Retinal fundus photograph:
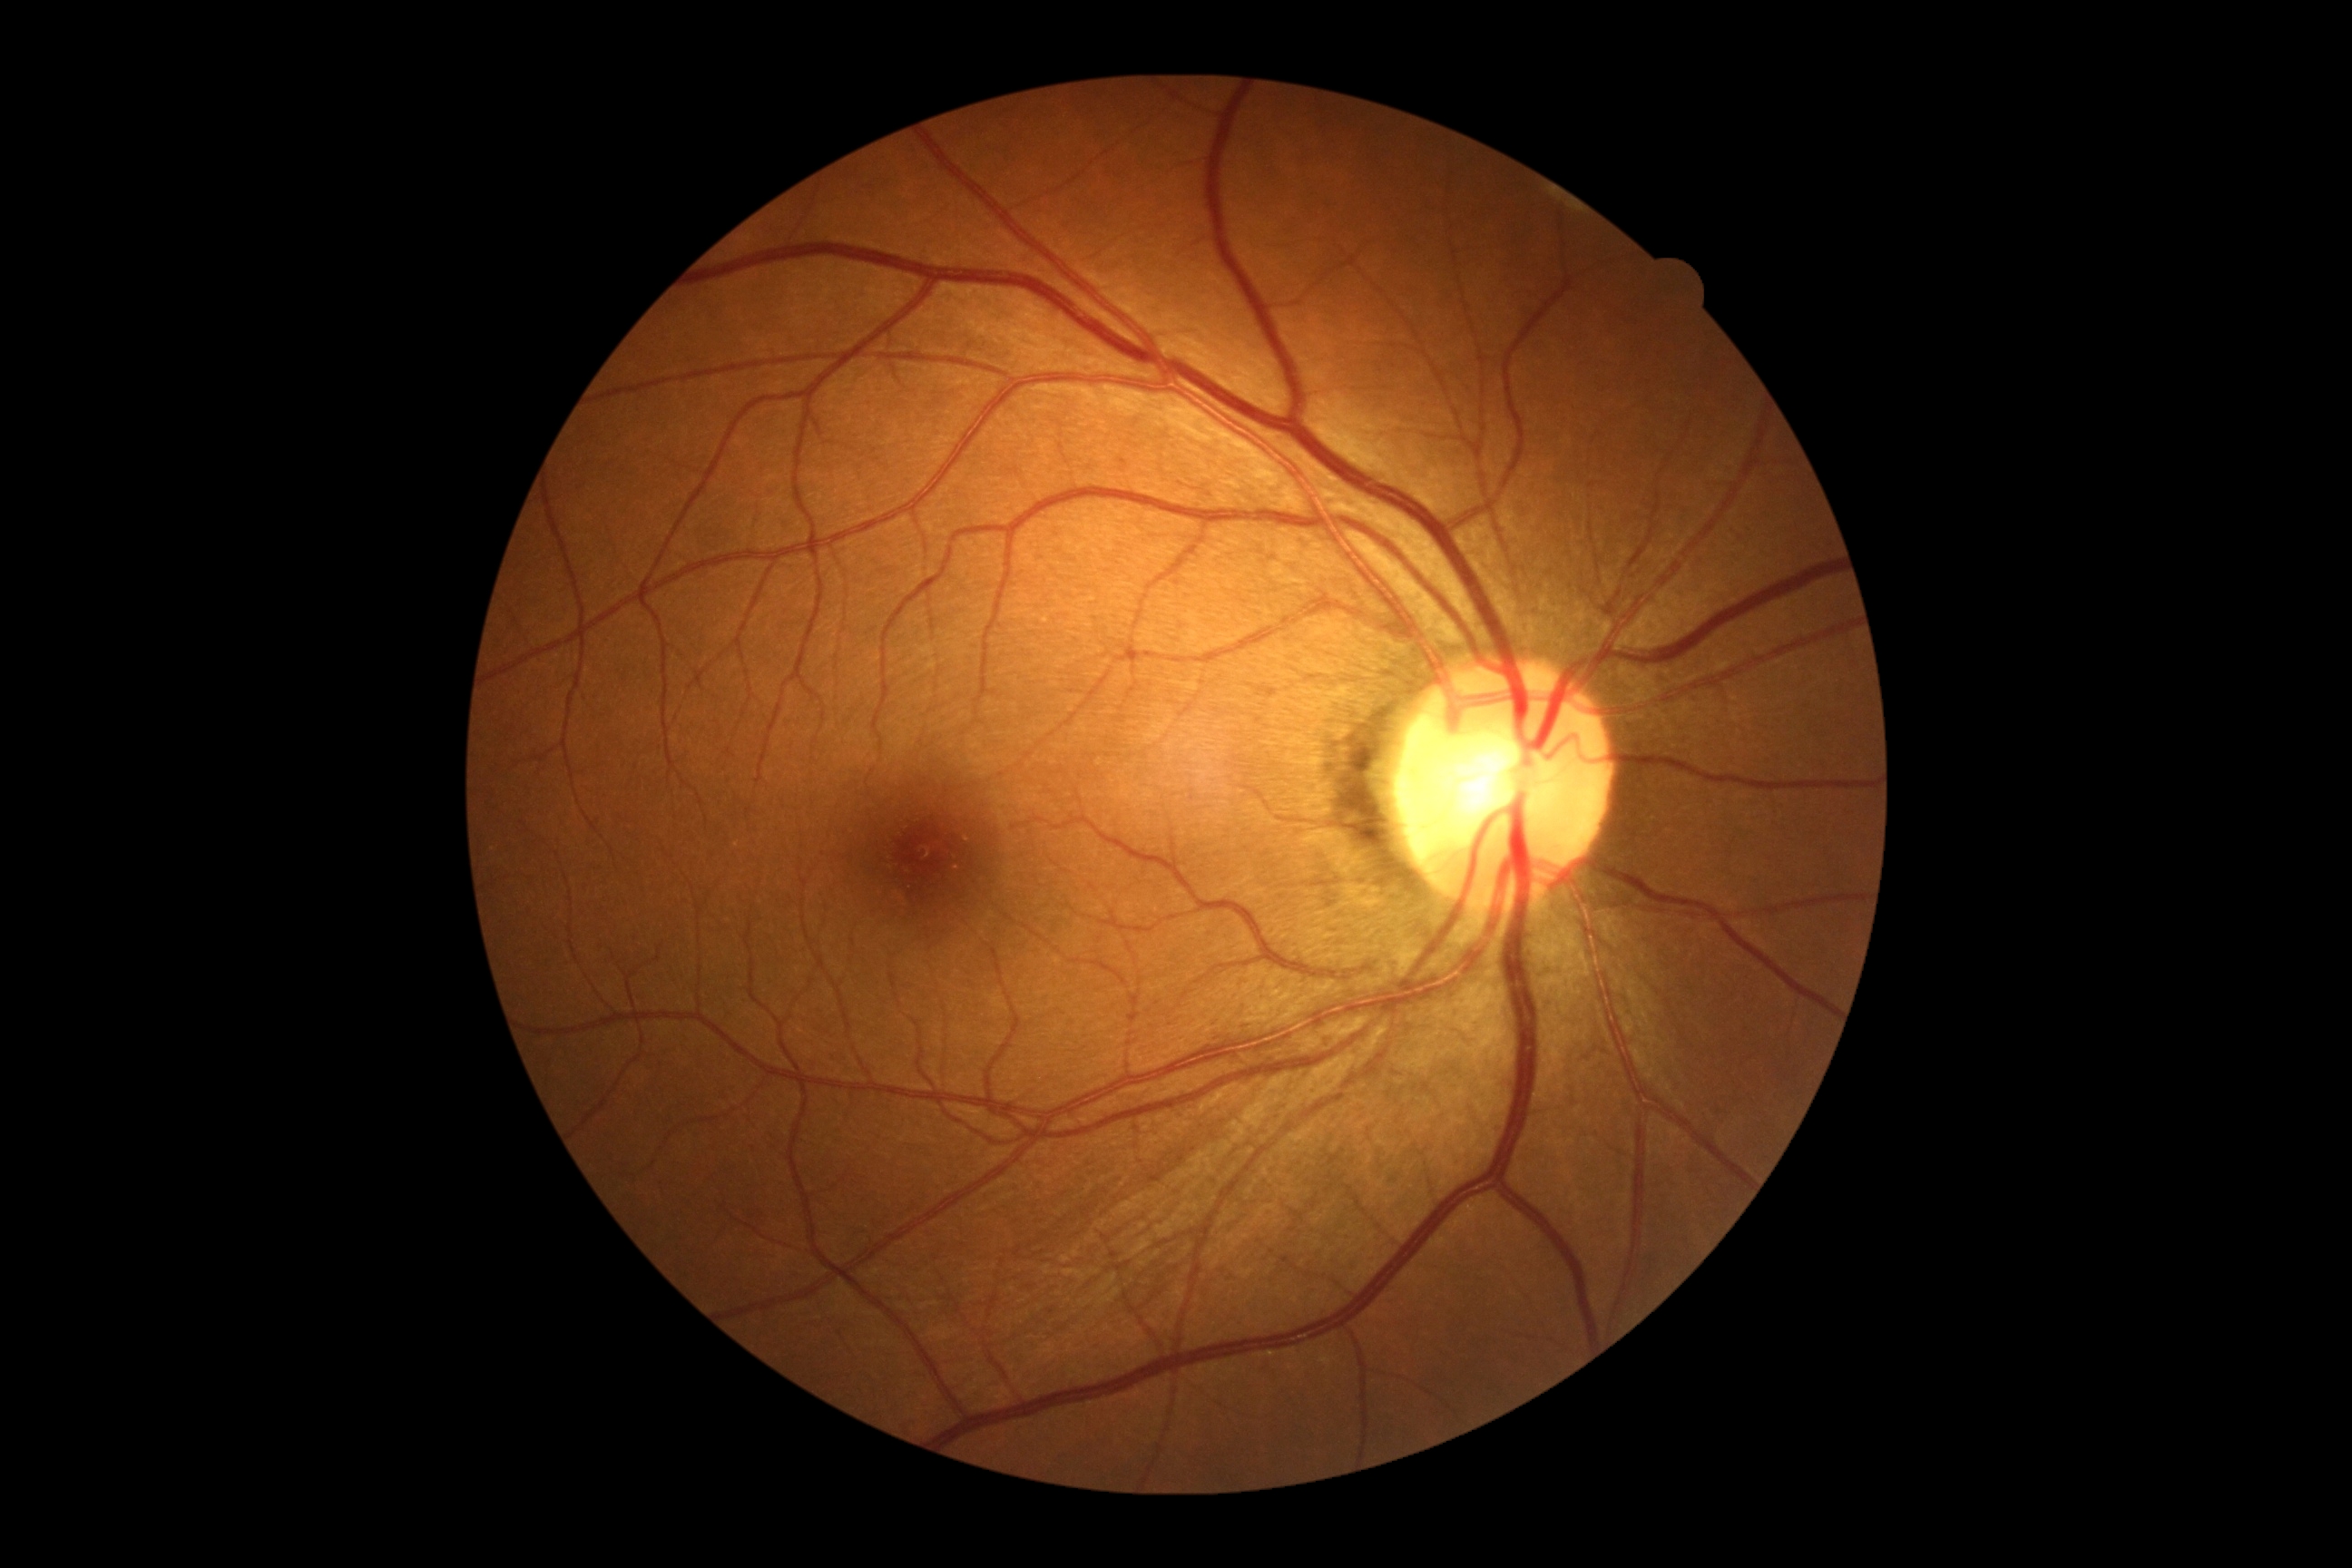
No DR findings. DR grade: 0.